45° field of view · 2352 x 1568 pixels
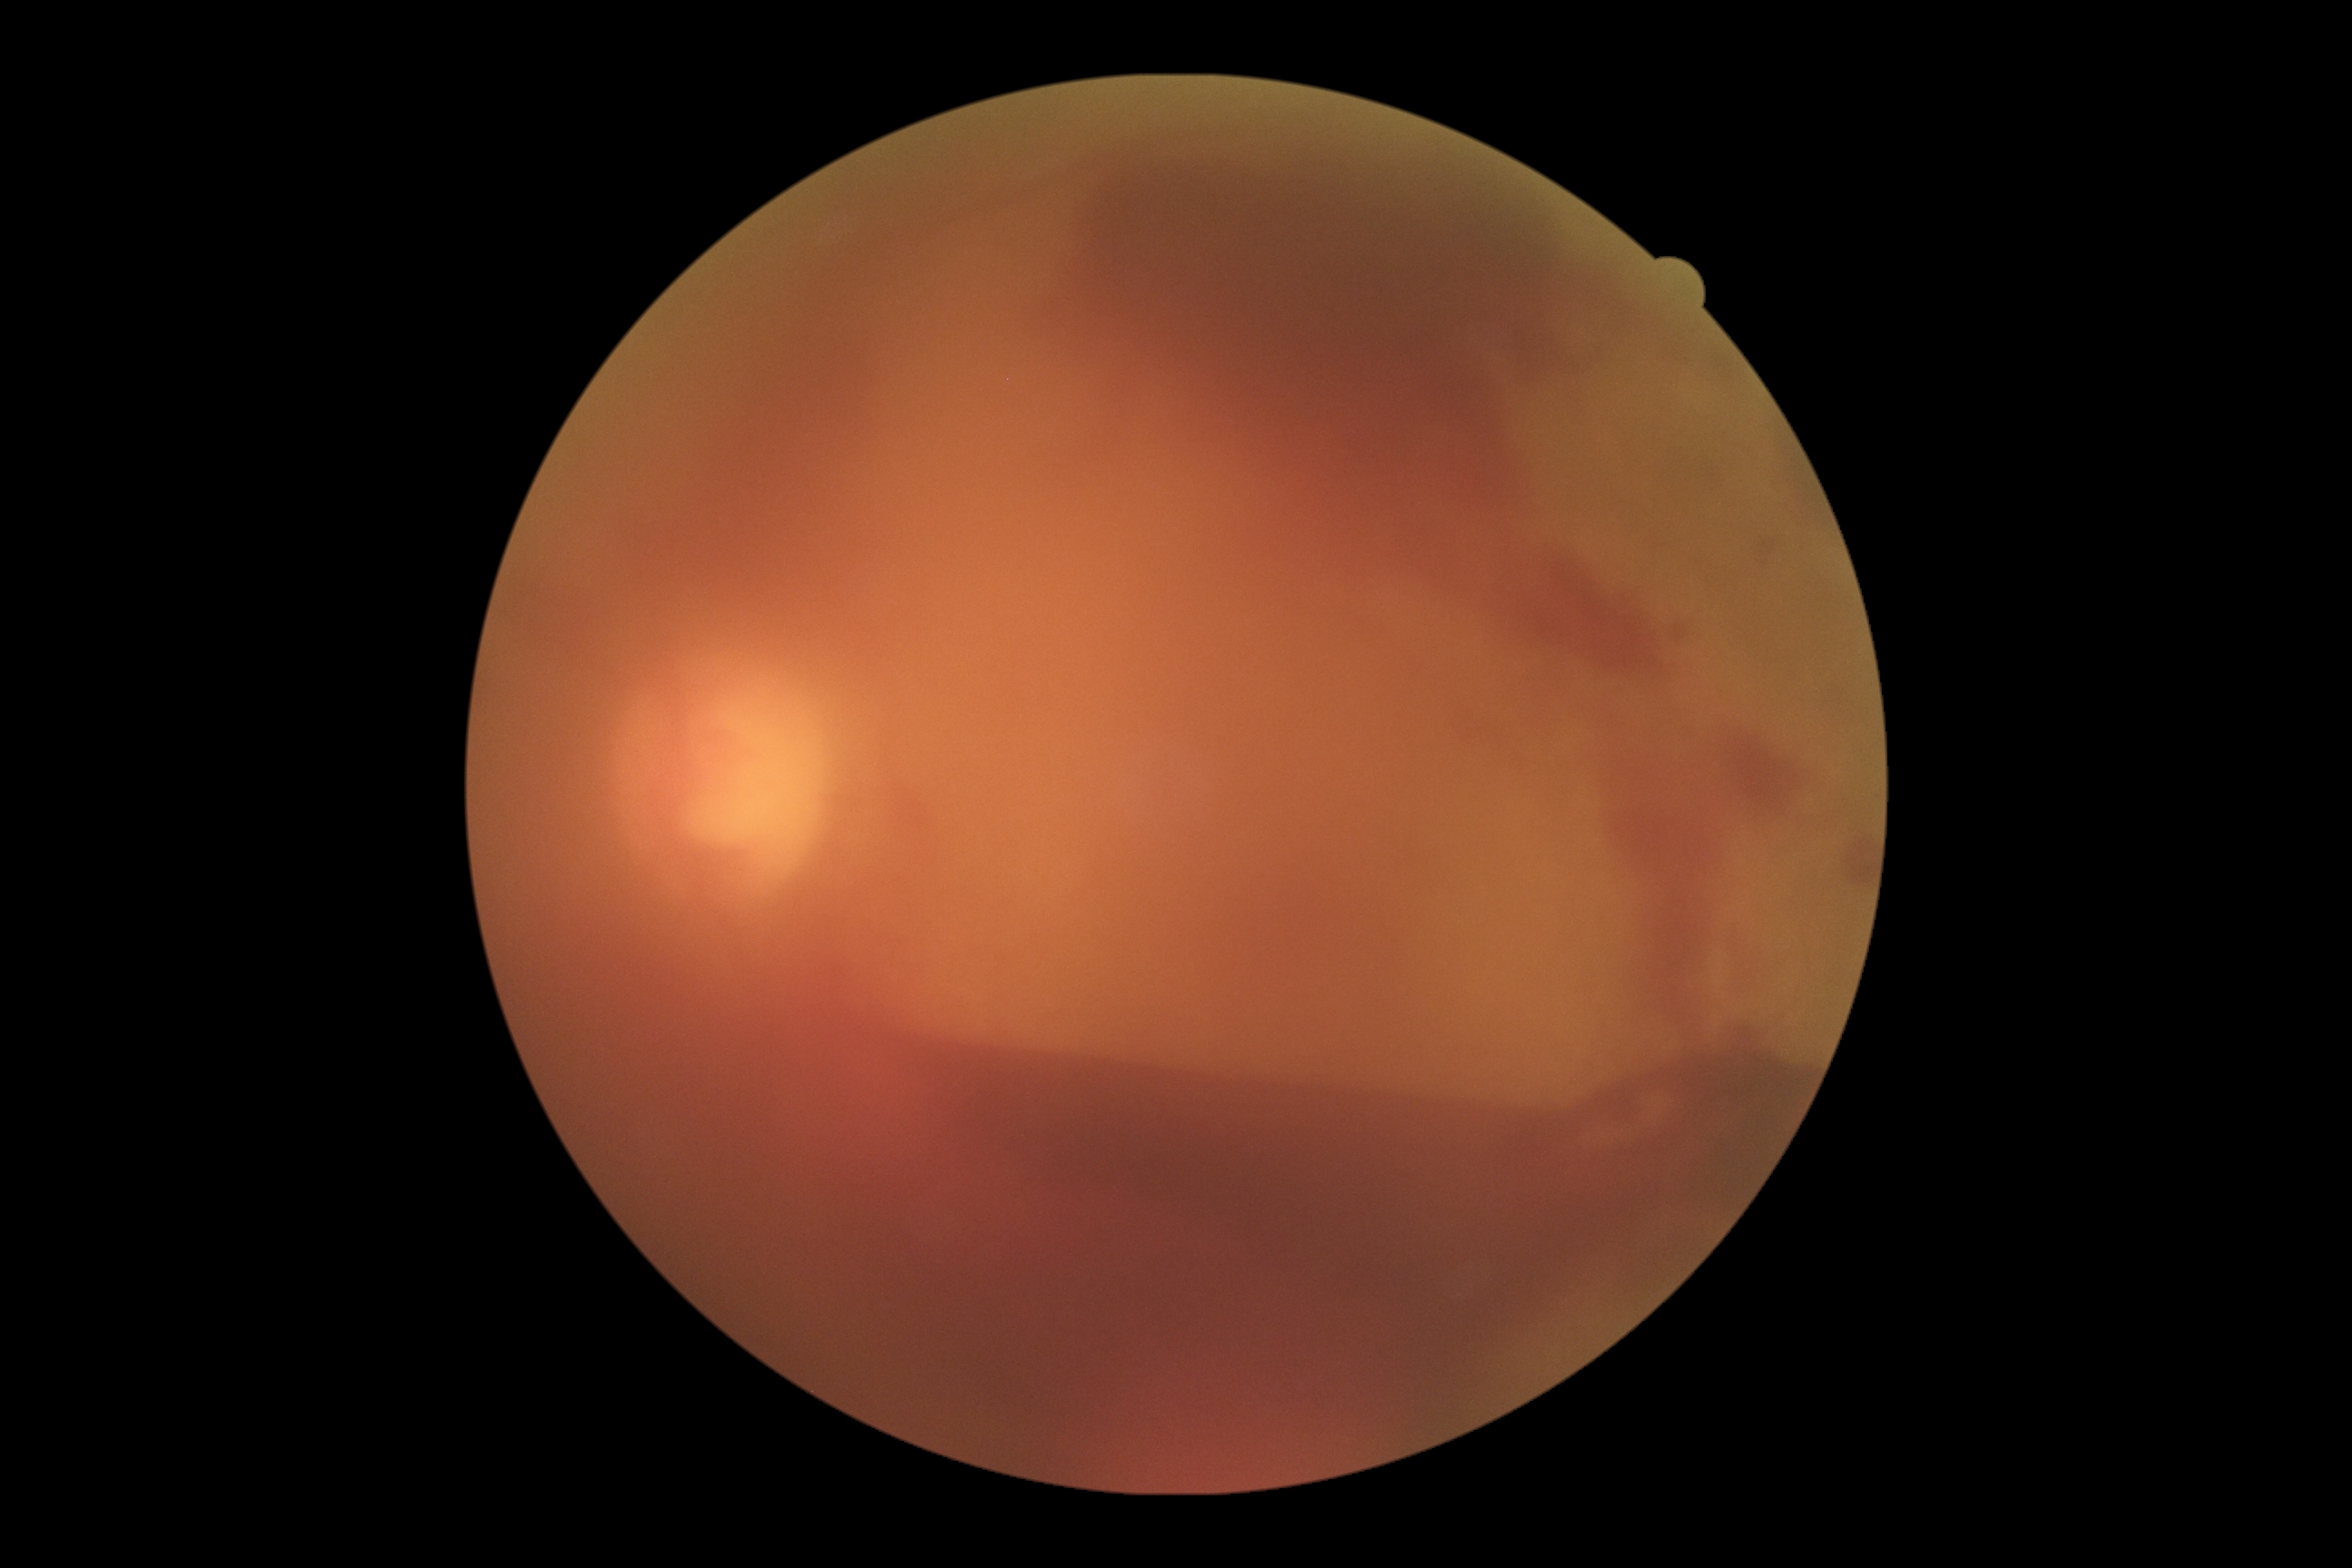
diabetic retinopathy (DR): proliferative diabetic retinopathy (grade 4) — neovascularization and/or vitreous/pre-retinal hemorrhage, DR class: proliferative diabetic retinopathy.